Optic disc at the center of the field. Female. Central corneal thickness 505 µm. 39 years old. Autorefraction: +0.75 -0.5 × 150° — 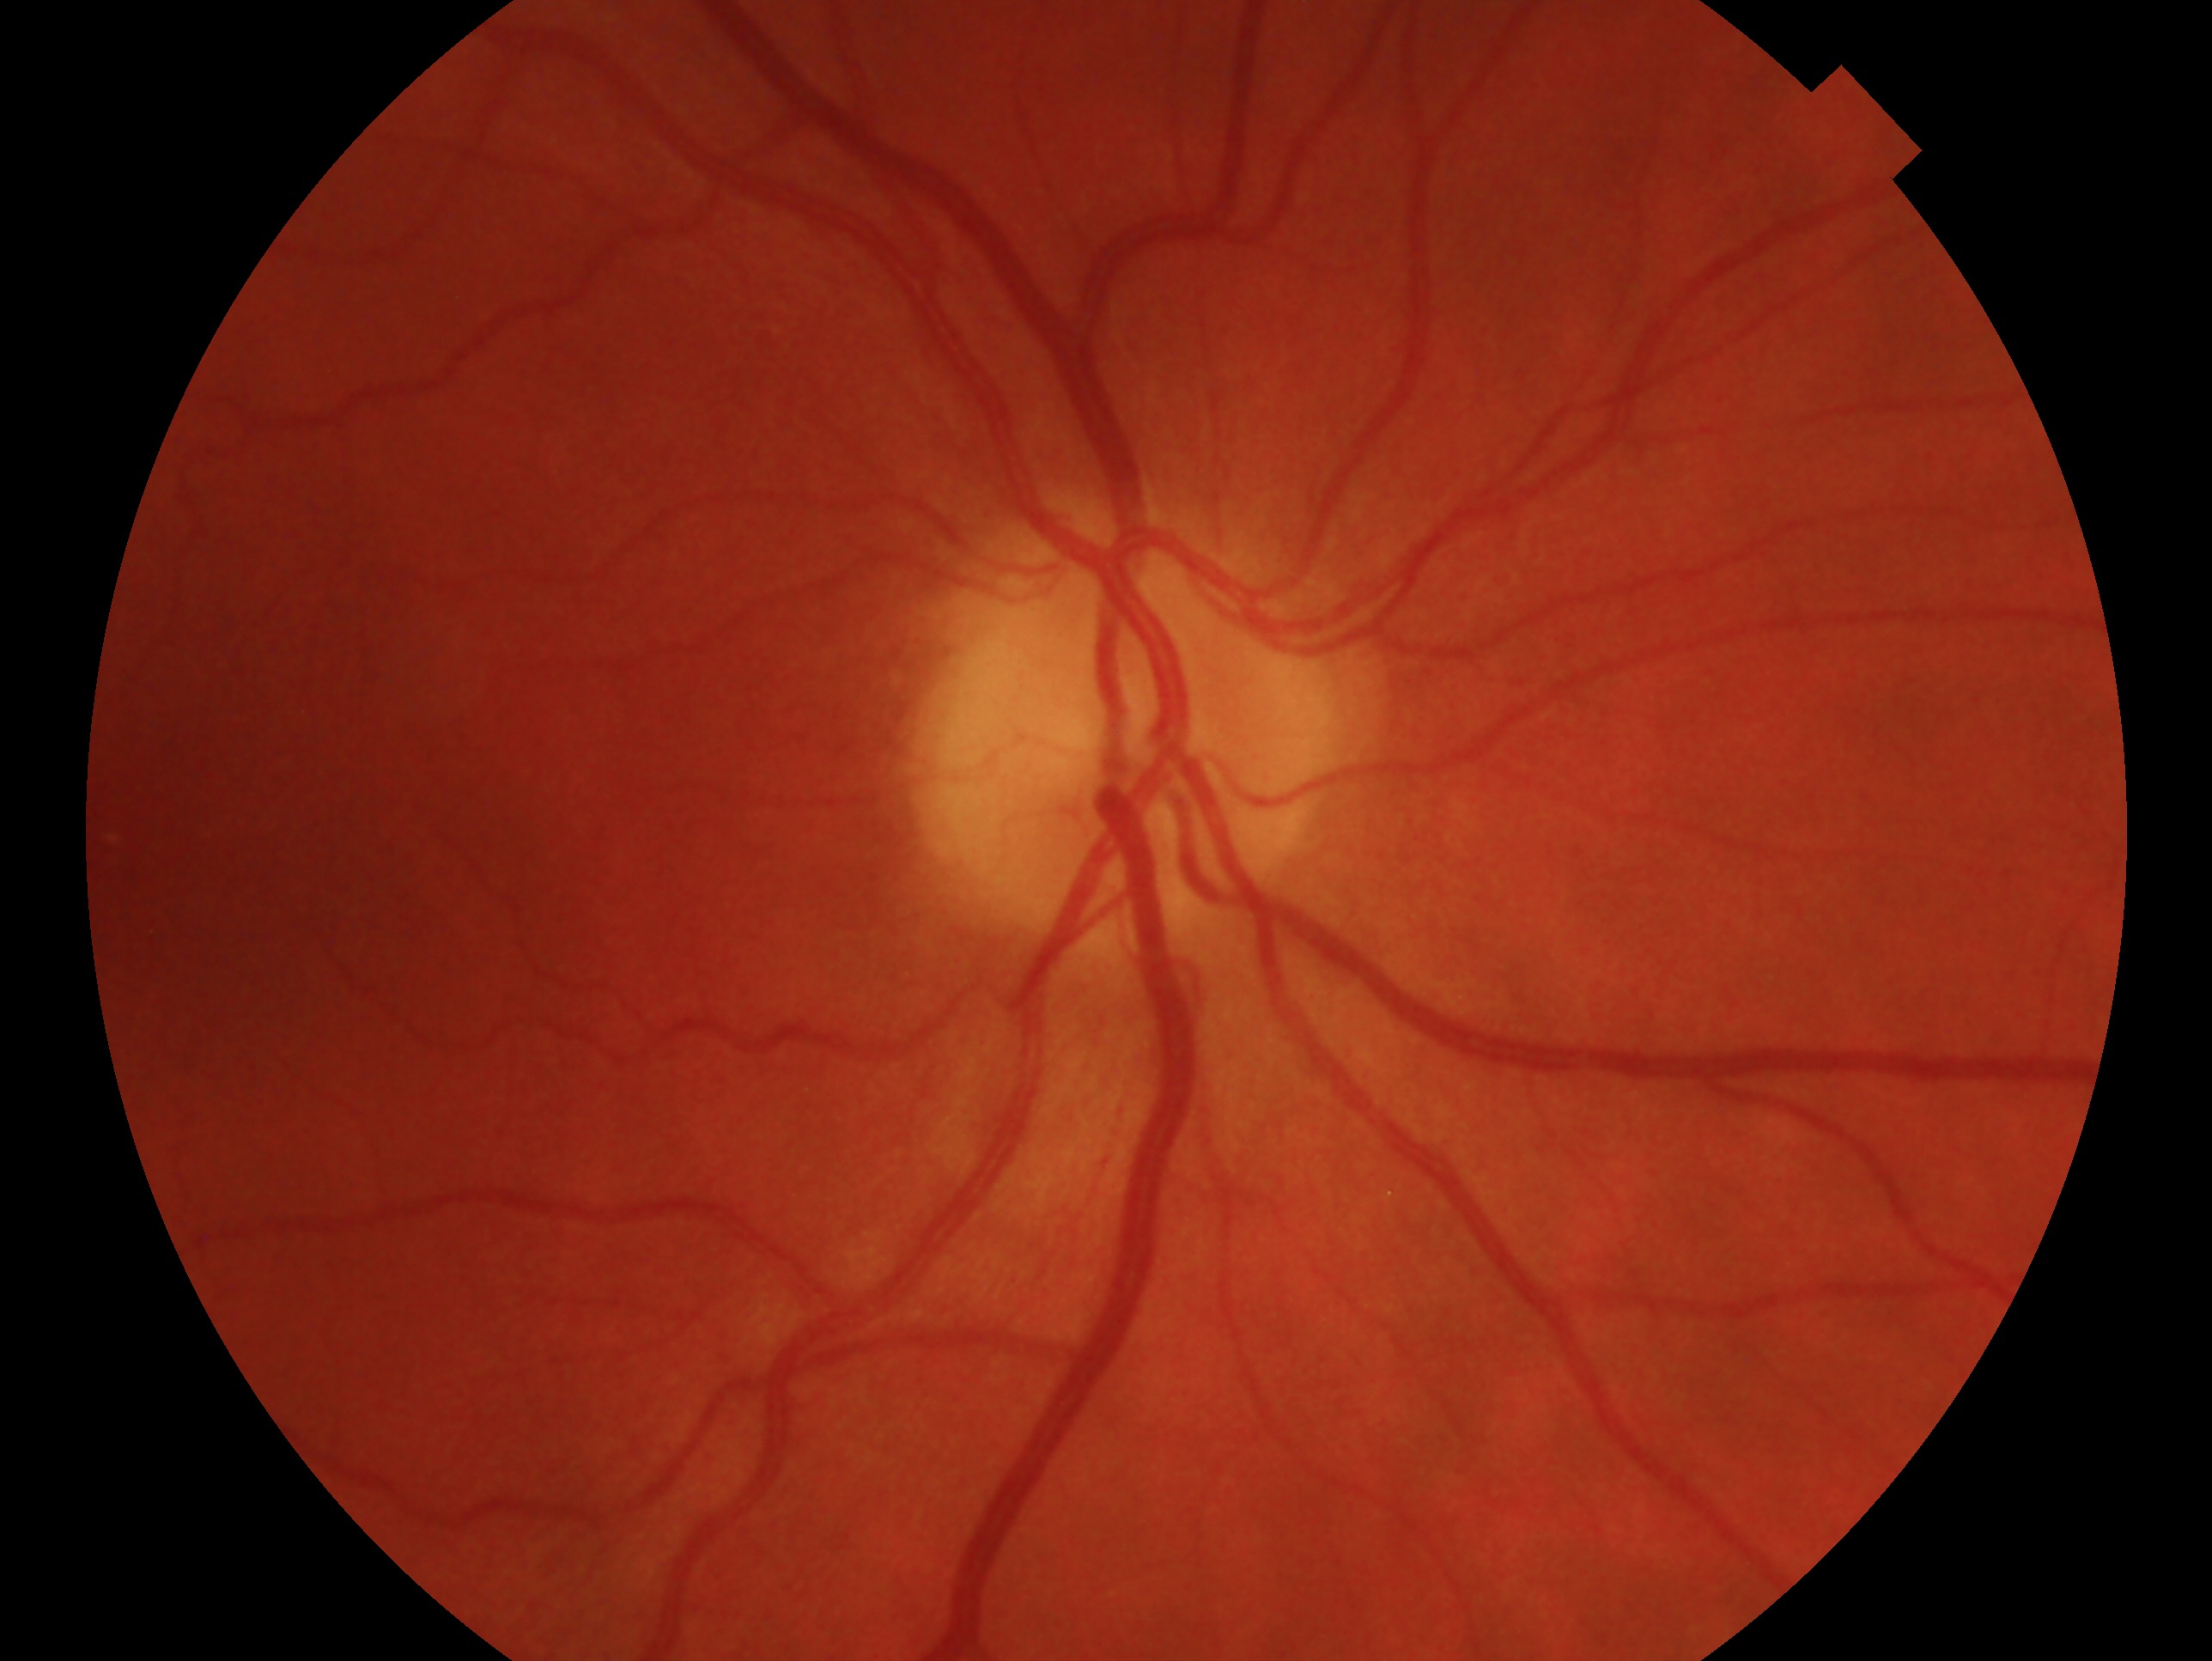 Clinical classification — no glaucoma. This is the right eye.